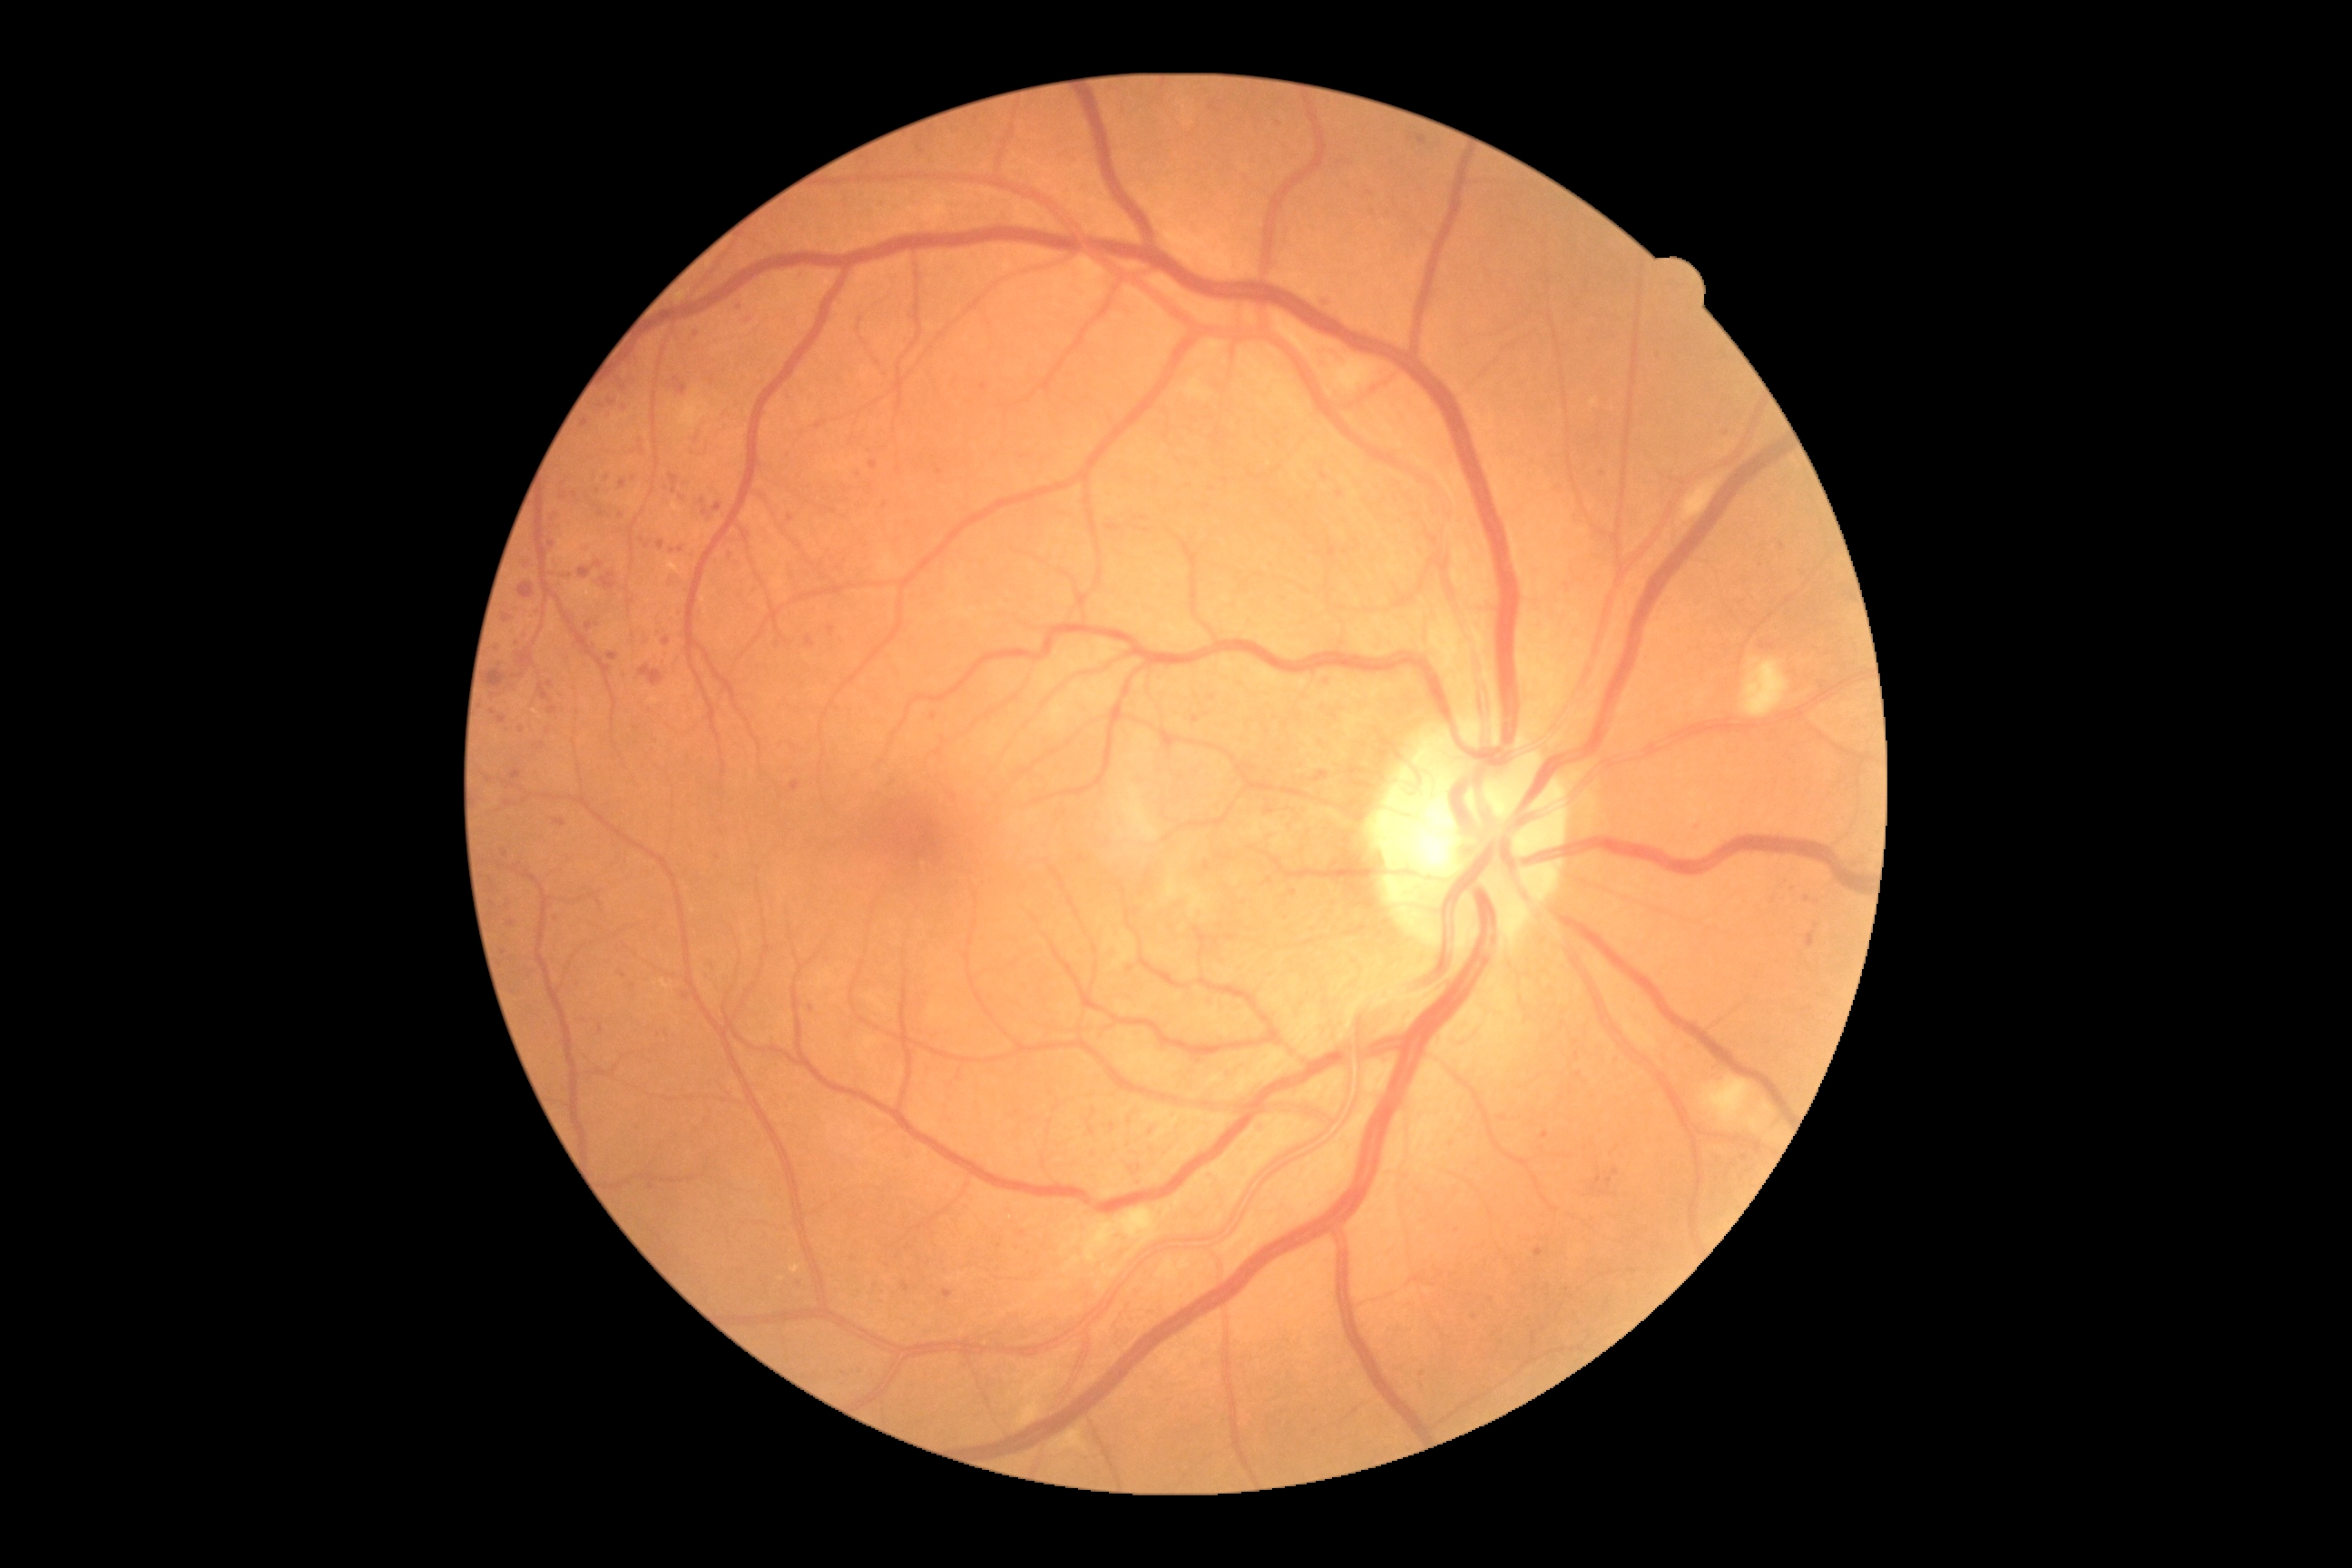 Diabetic retinopathy (DR) is grade 2 (moderate NPDR). Microaneurysms (MAs) include lesions at {"left": 1090, "top": 1126, "right": 1095, "bottom": 1135}; {"left": 1534, "top": 1248, "right": 1545, "bottom": 1257}; {"left": 502, "top": 614, "right": 513, "bottom": 623}; {"left": 620, "top": 480, "right": 627, "bottom": 489}; {"left": 672, "top": 612, "right": 680, "bottom": 616}. Small MAs near (680; 550); (556; 919); (1545; 1135); (861; 1371); (885; 505); (535; 612); (608; 478); (1130; 969); (1578; 1060); (552; 545); (1213; 109); (493; 713).